1240x1240px. Wide-field fundus photograph from neonatal ROP screening. 100° field of view (Phoenix ICON) — 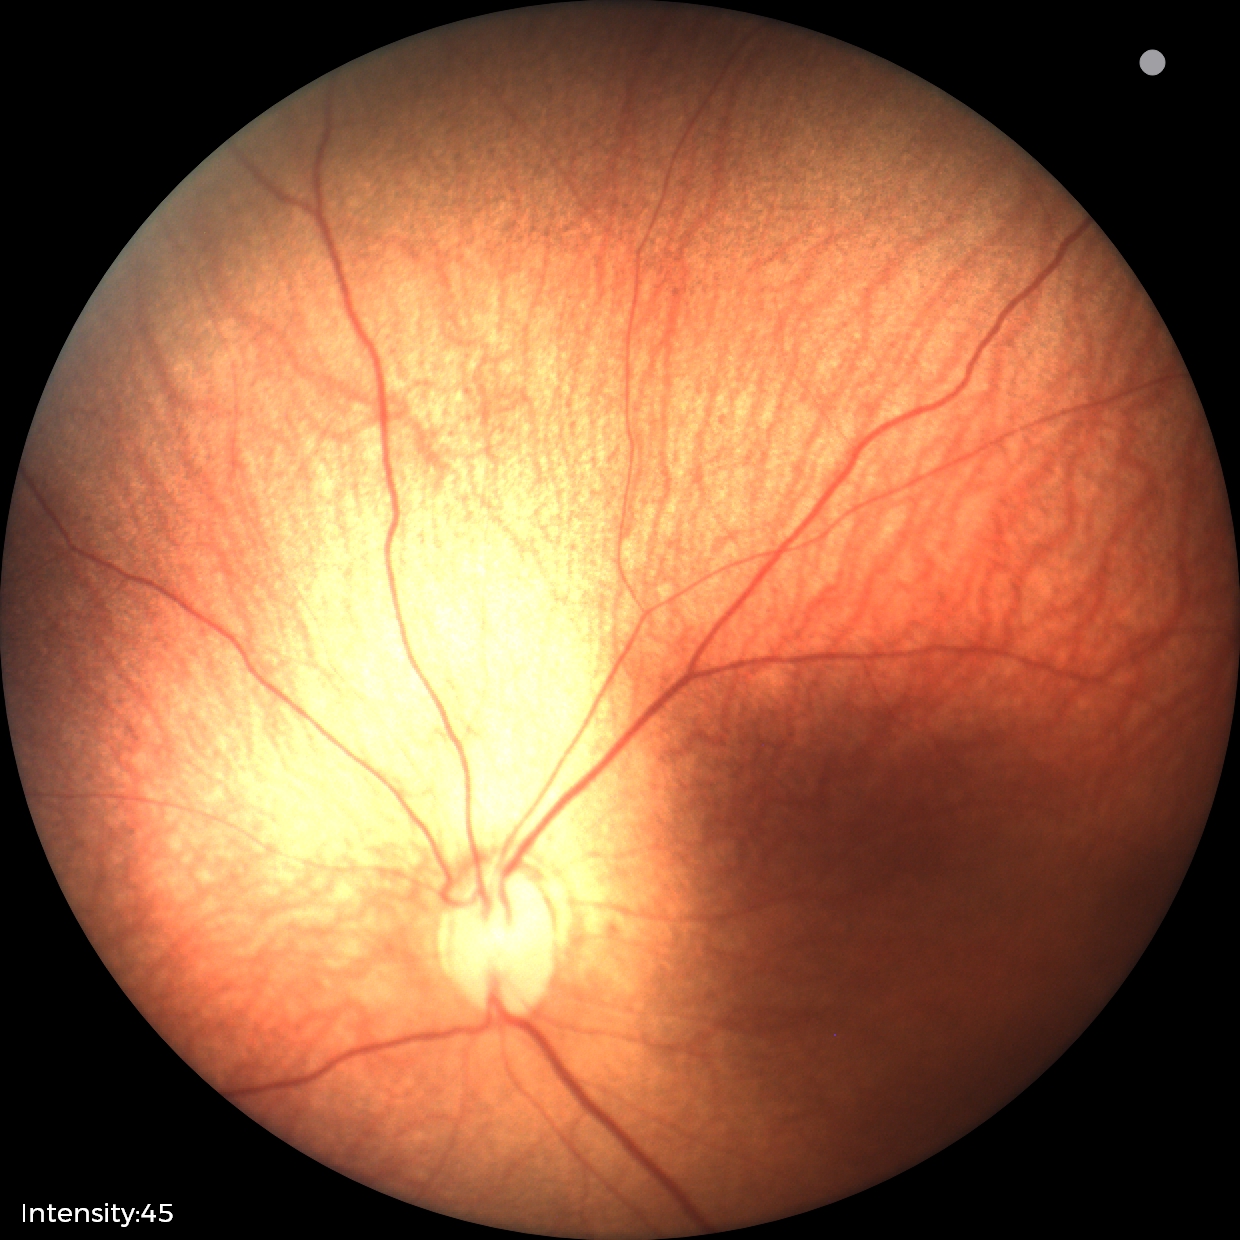

Examination diagnosed as retinopathy of prematurity stage 1.